Centered on the macula, 1932 x 1932 pixels:
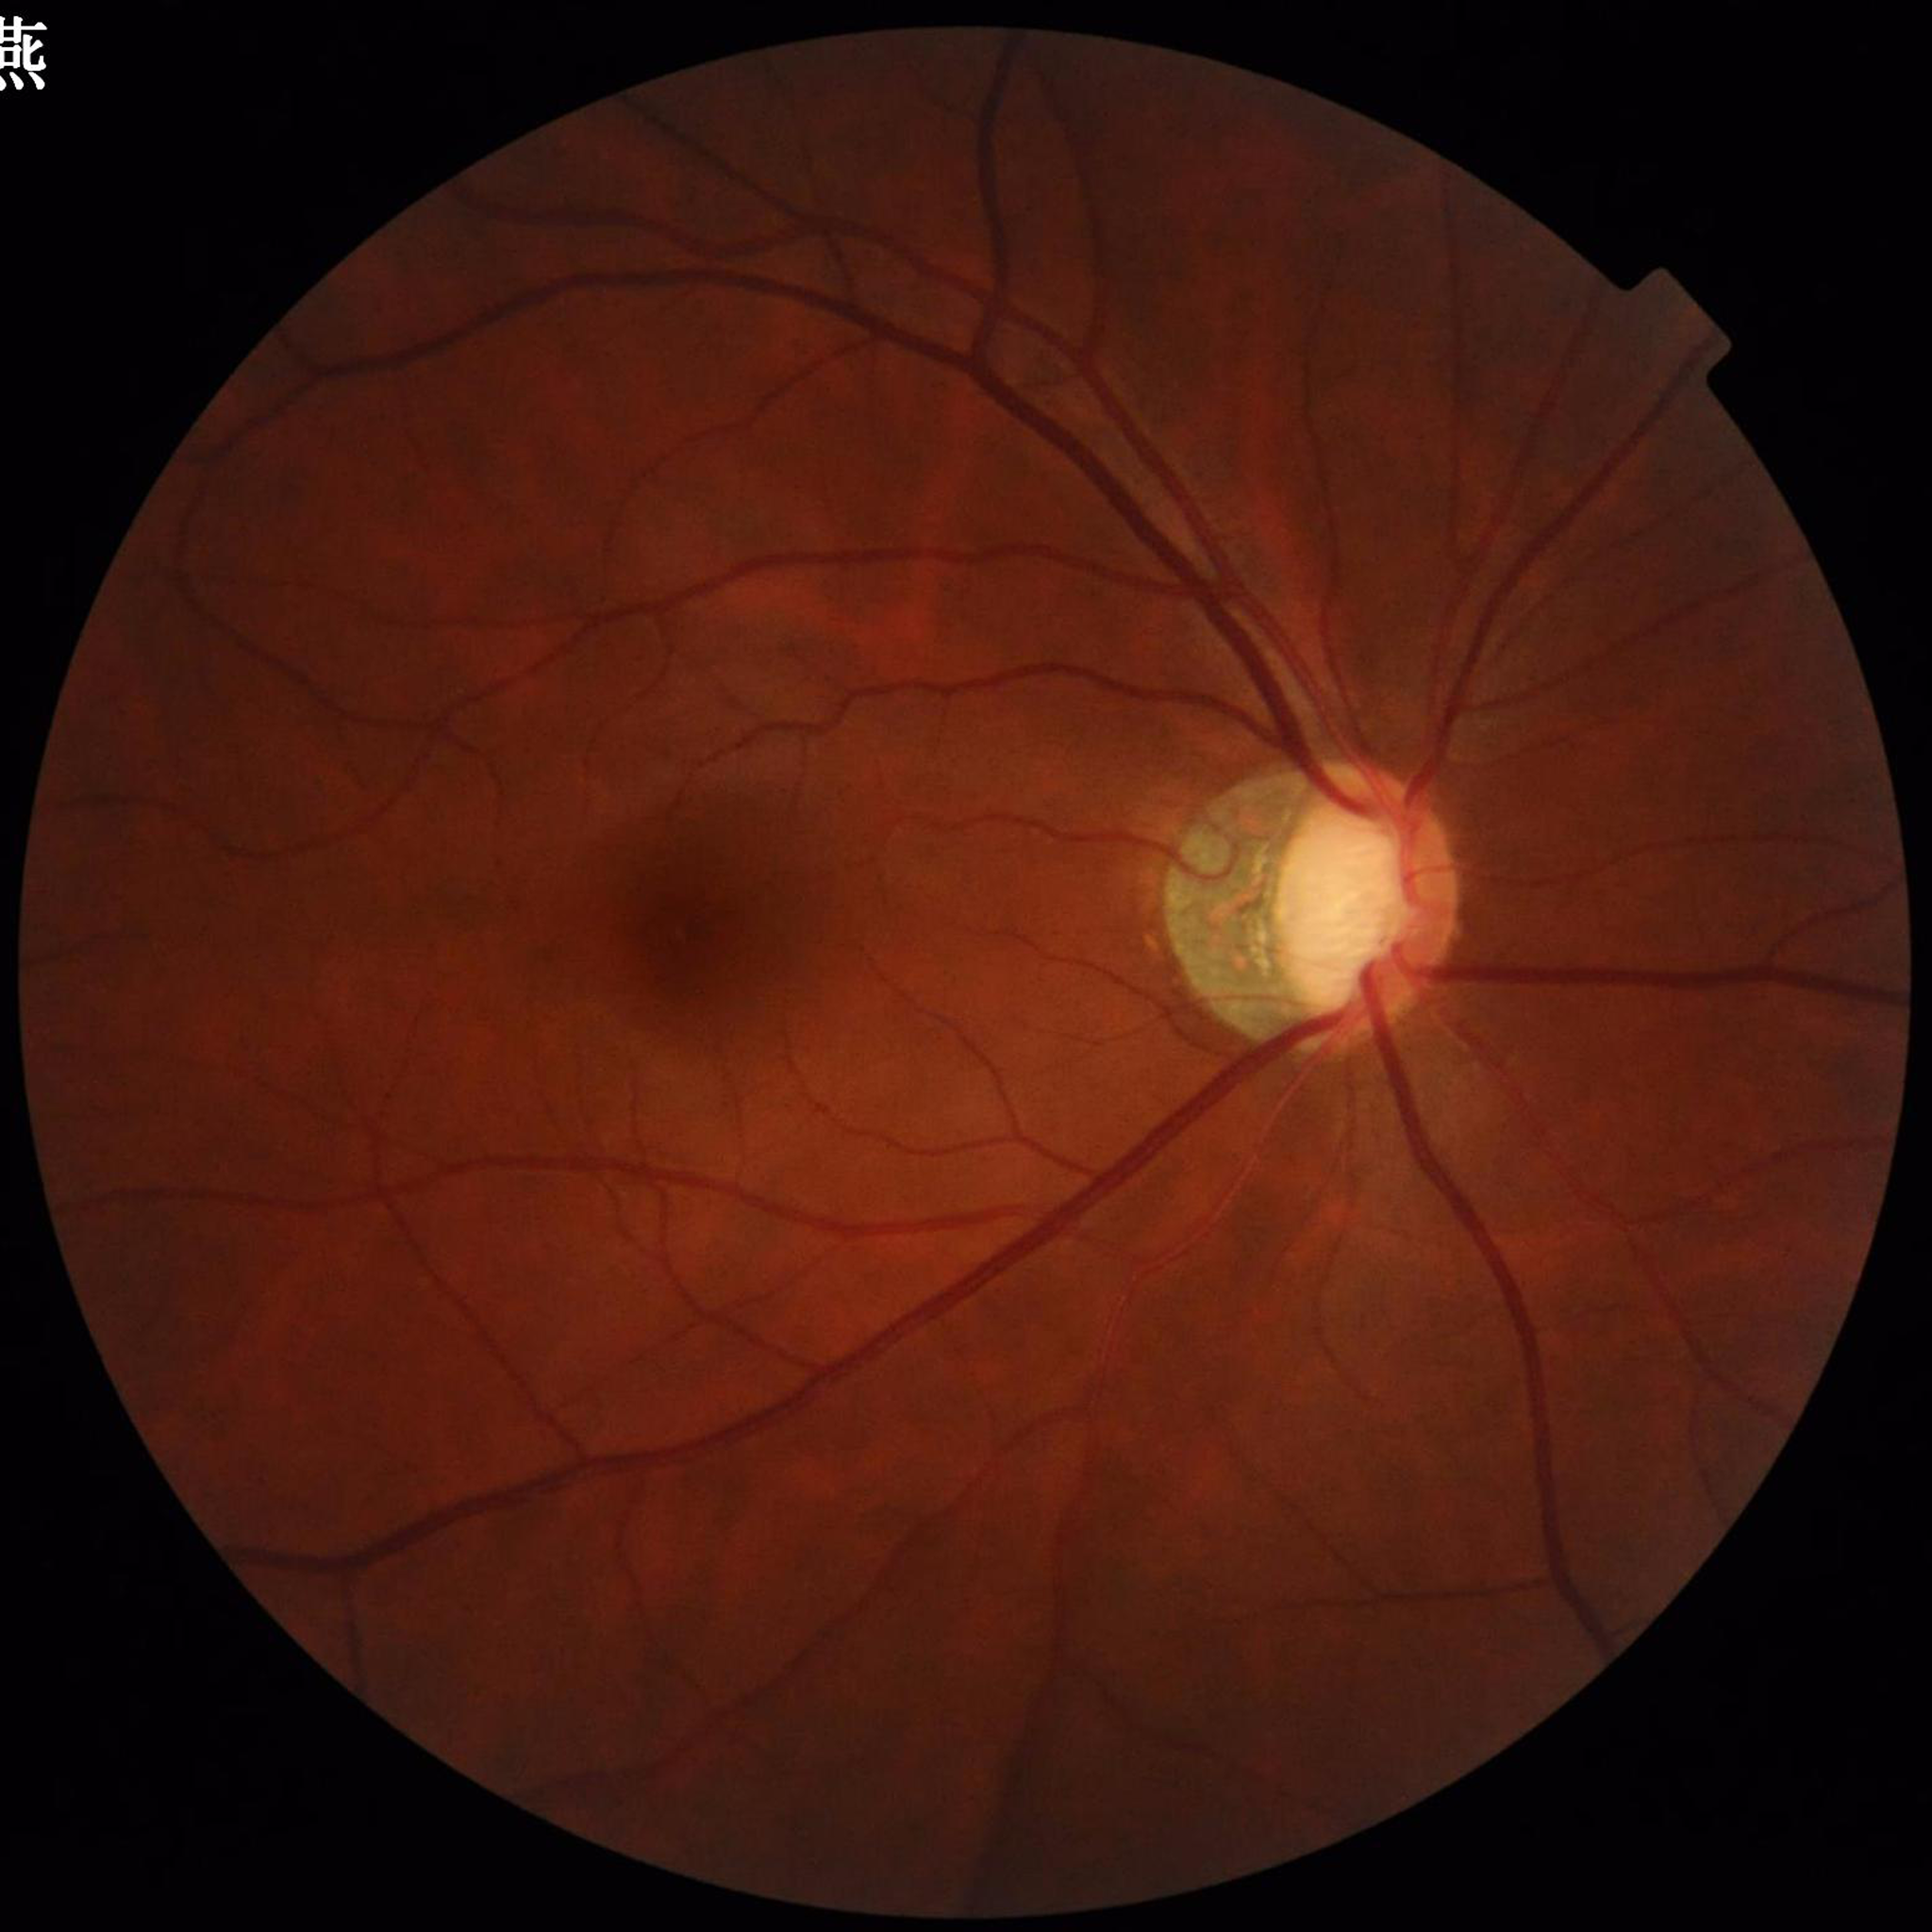
Photo quality: adequate.
Diagnosed with glaucoma.